Color fundus image, 1932 x 1910 pixels
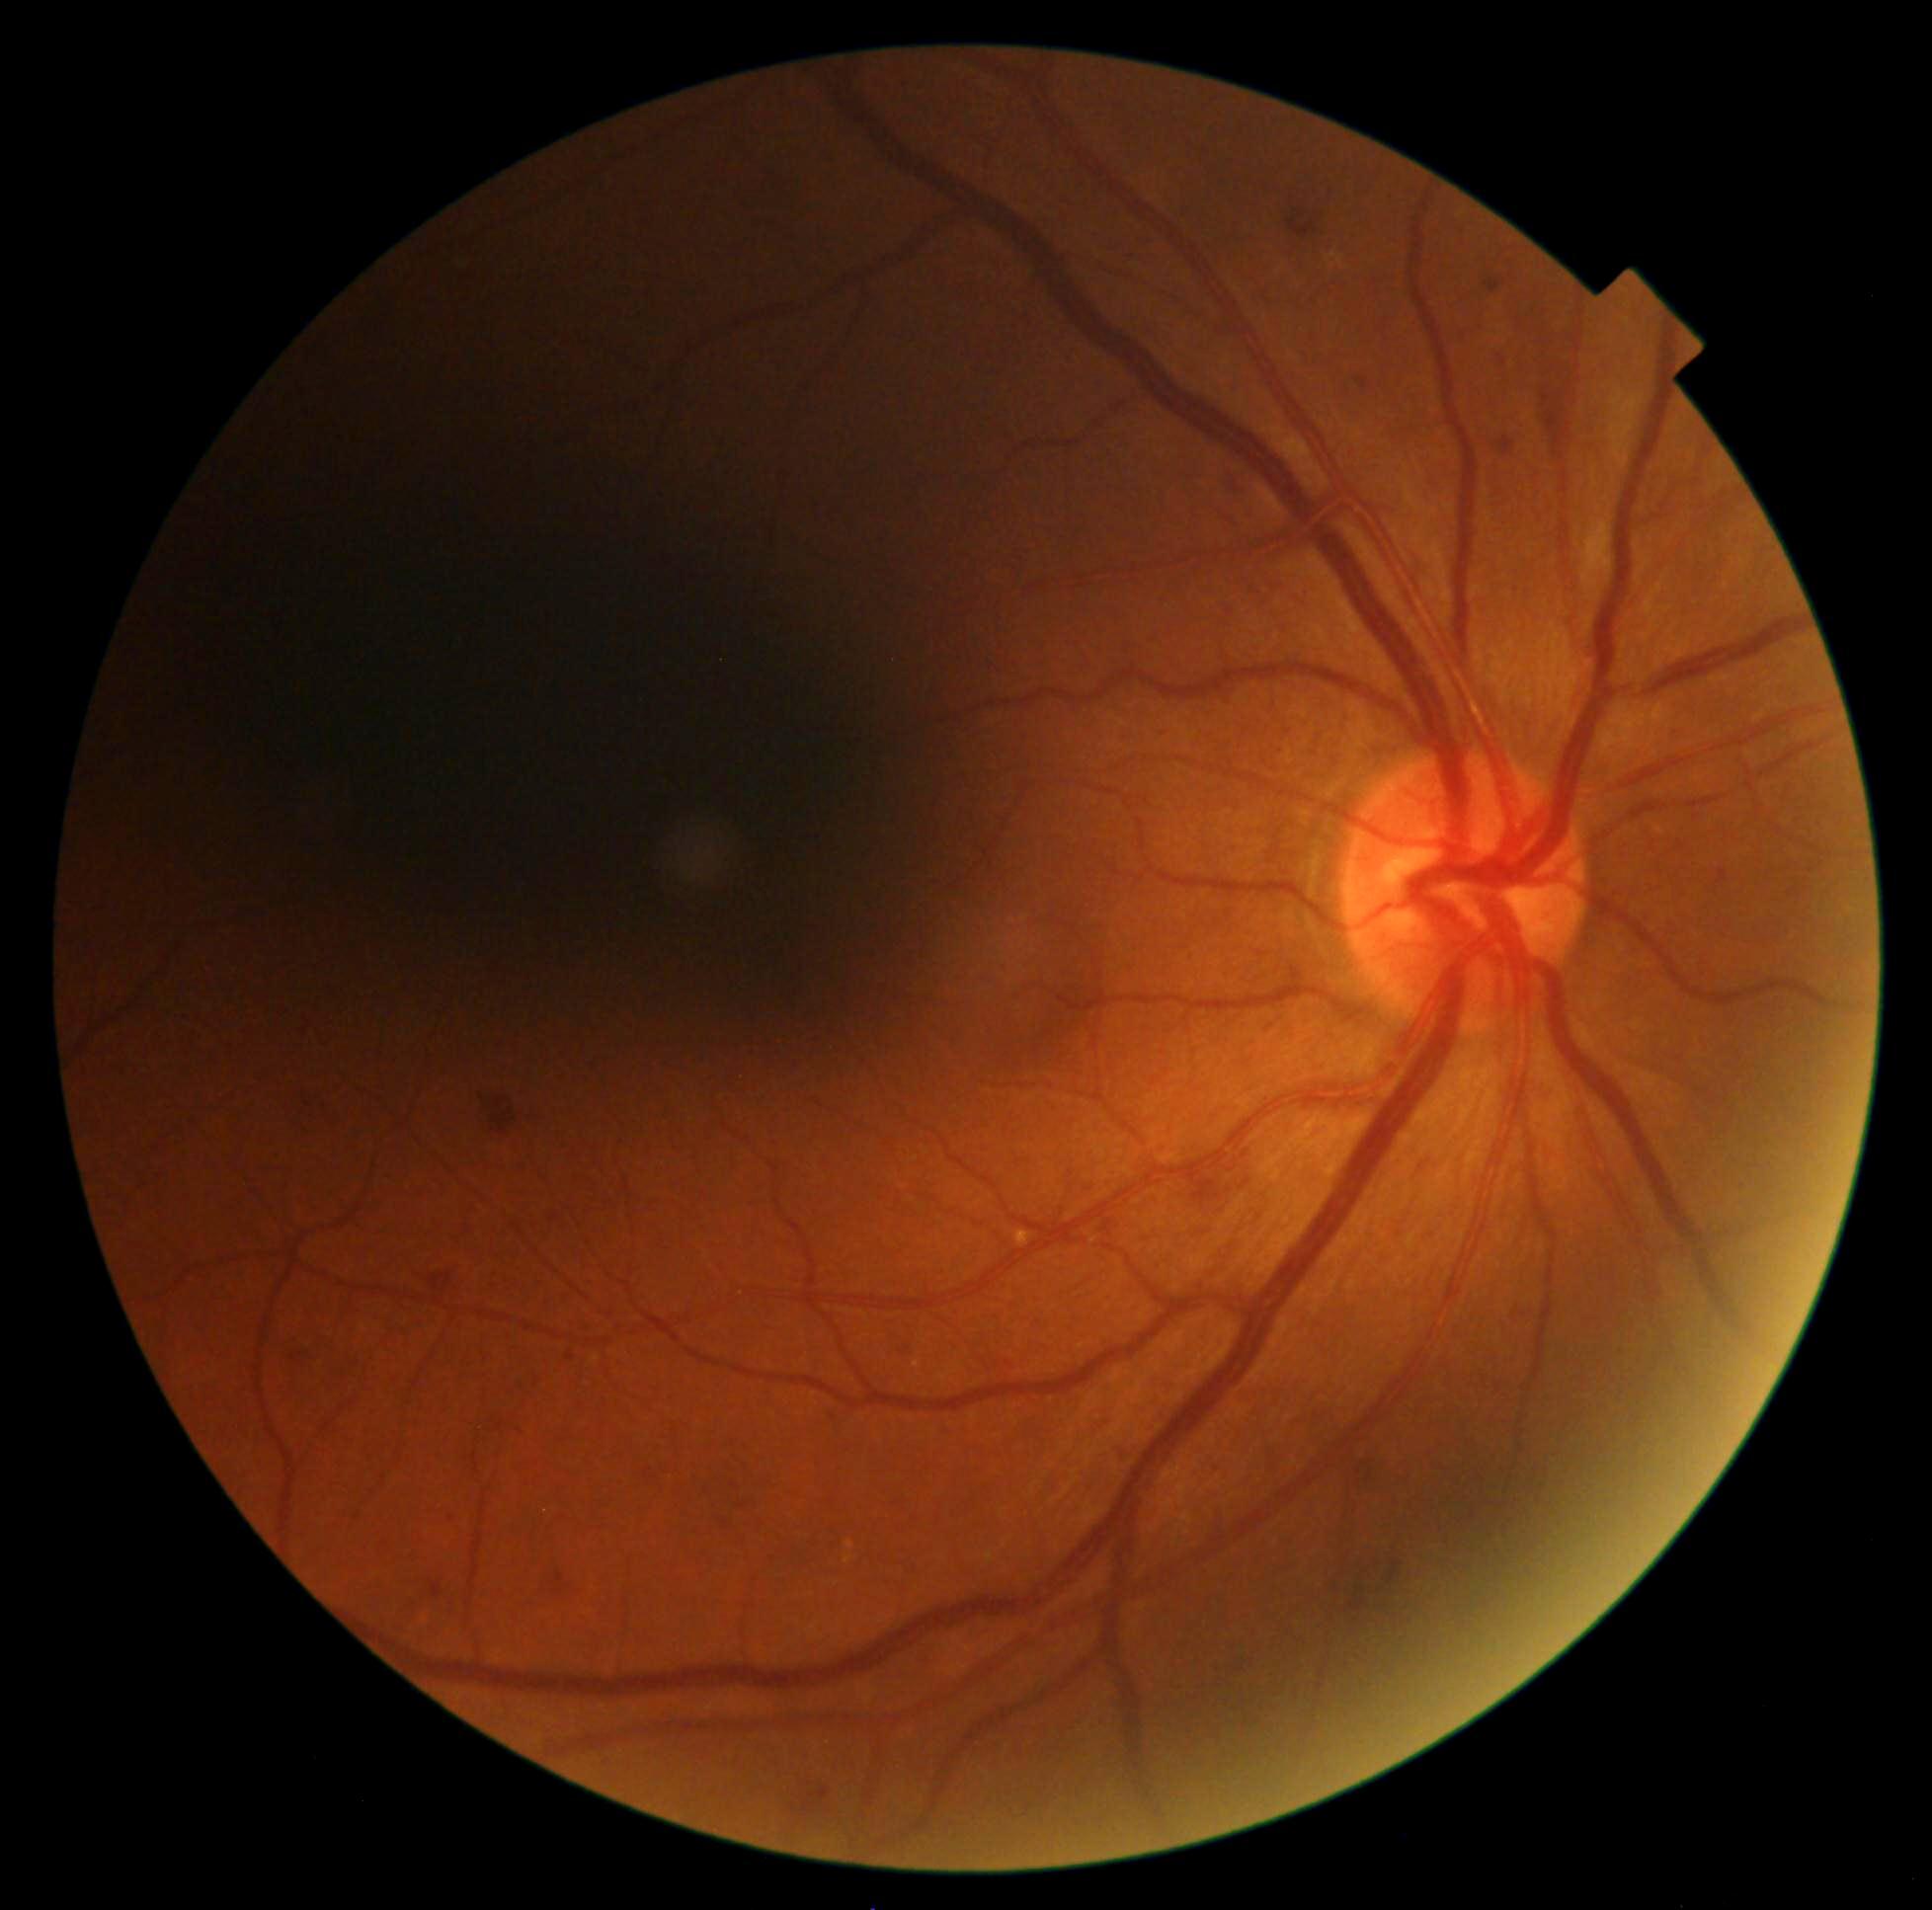

Retinopathy grade: 2 — more than just microaneurysms but less than severe NPDR.